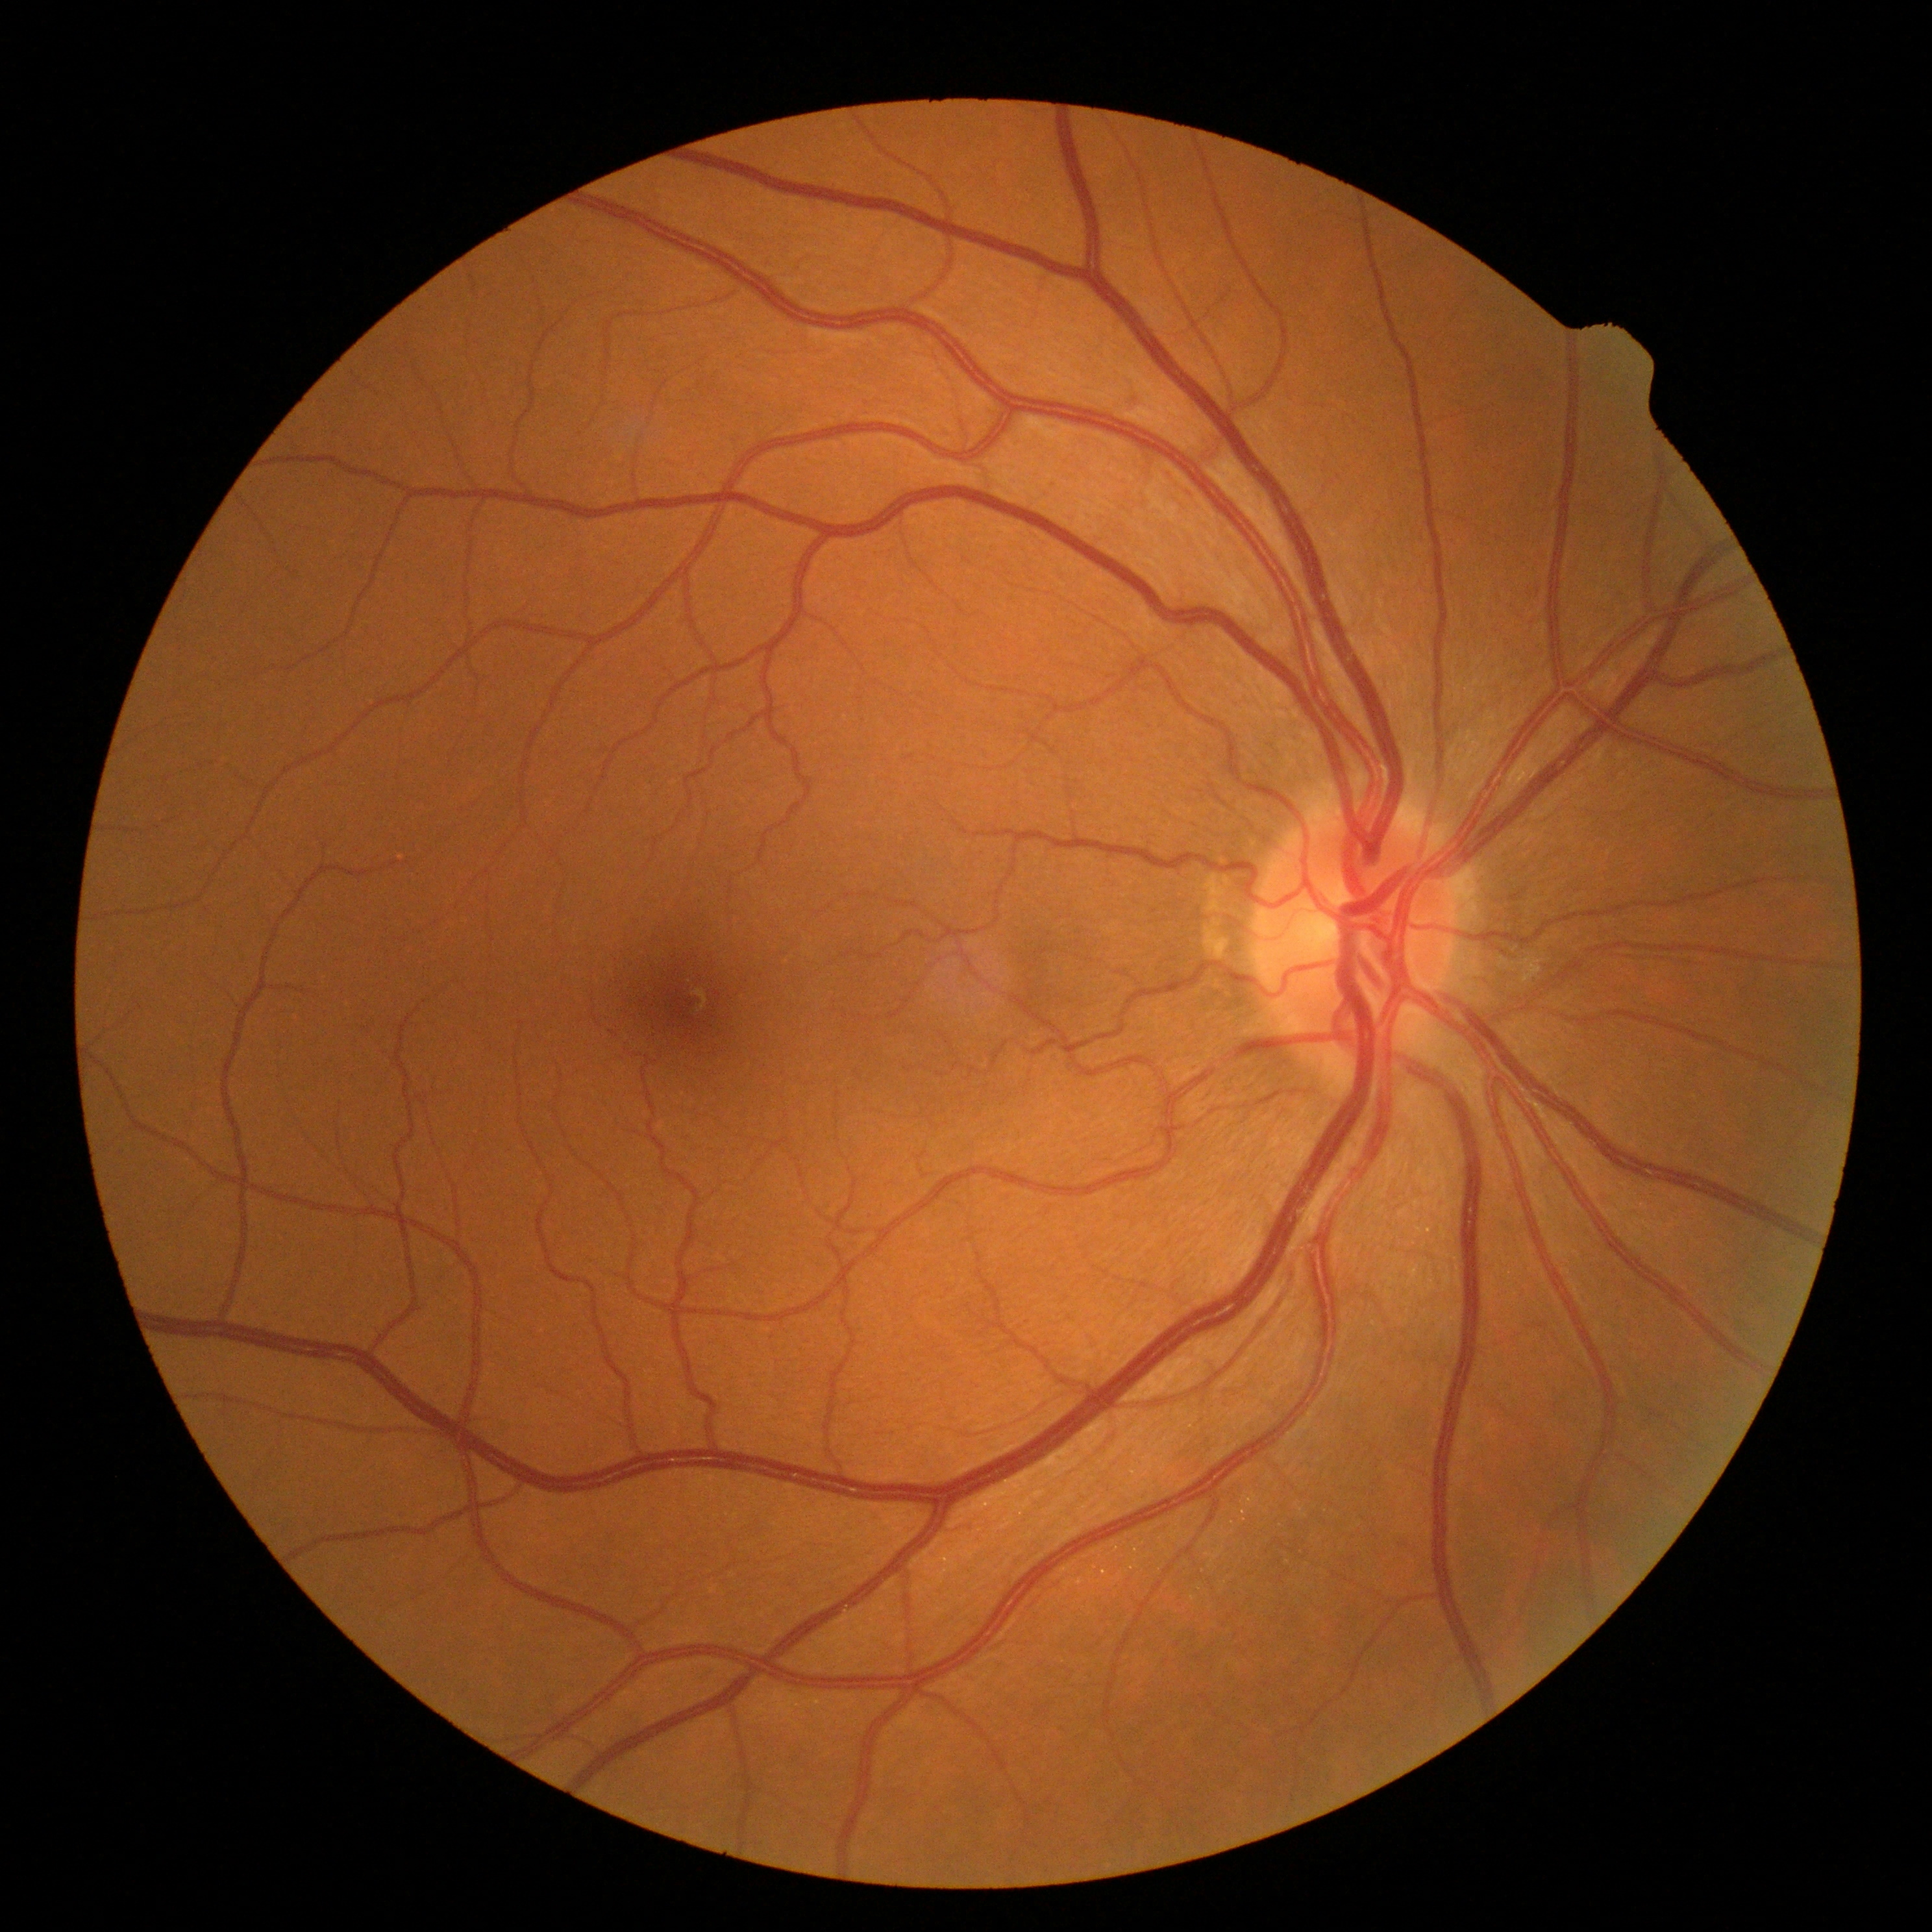

DR@0/4.